Graded on the modified Davis scale
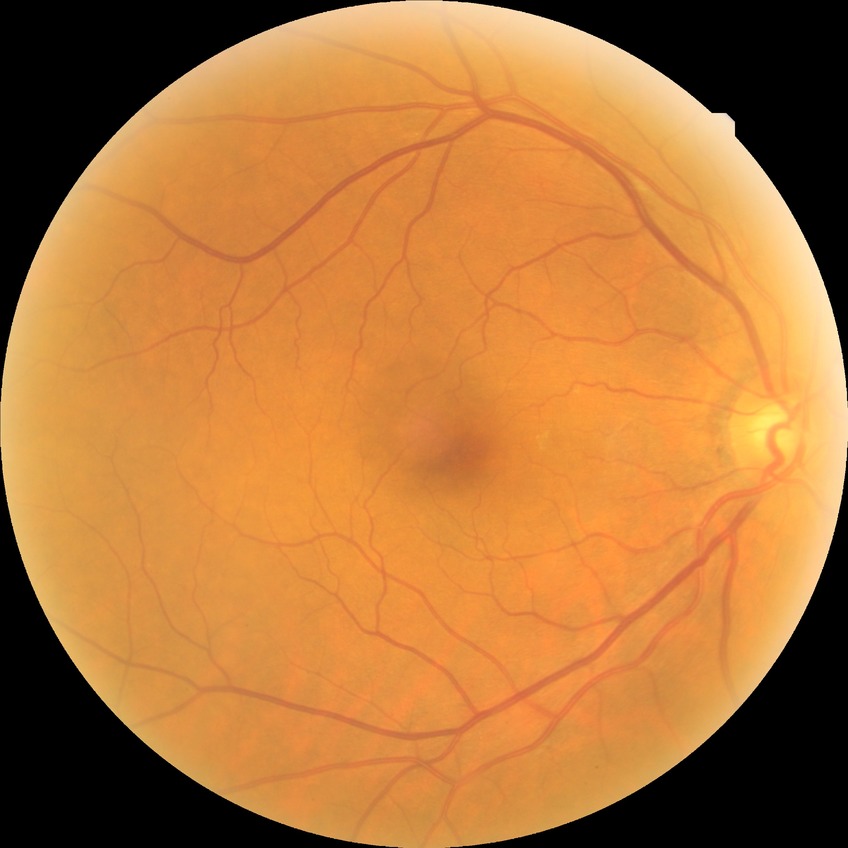

diabetic retinopathy (DR) = no diabetic retinopathy (NDR).